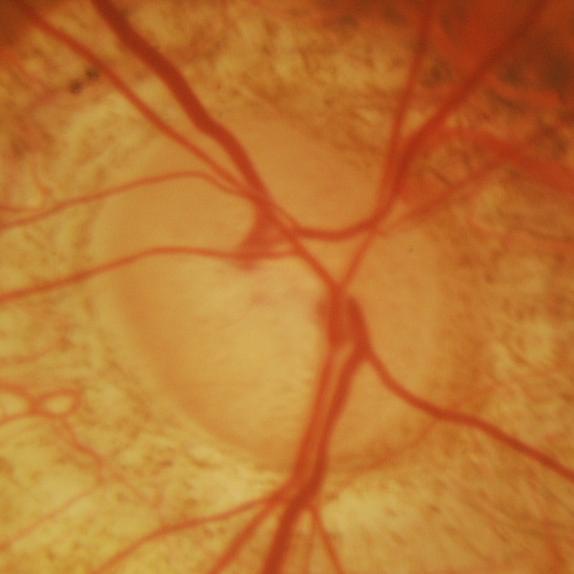

ONH-centered fundus image showing glaucomatous damage to the optic nerve.